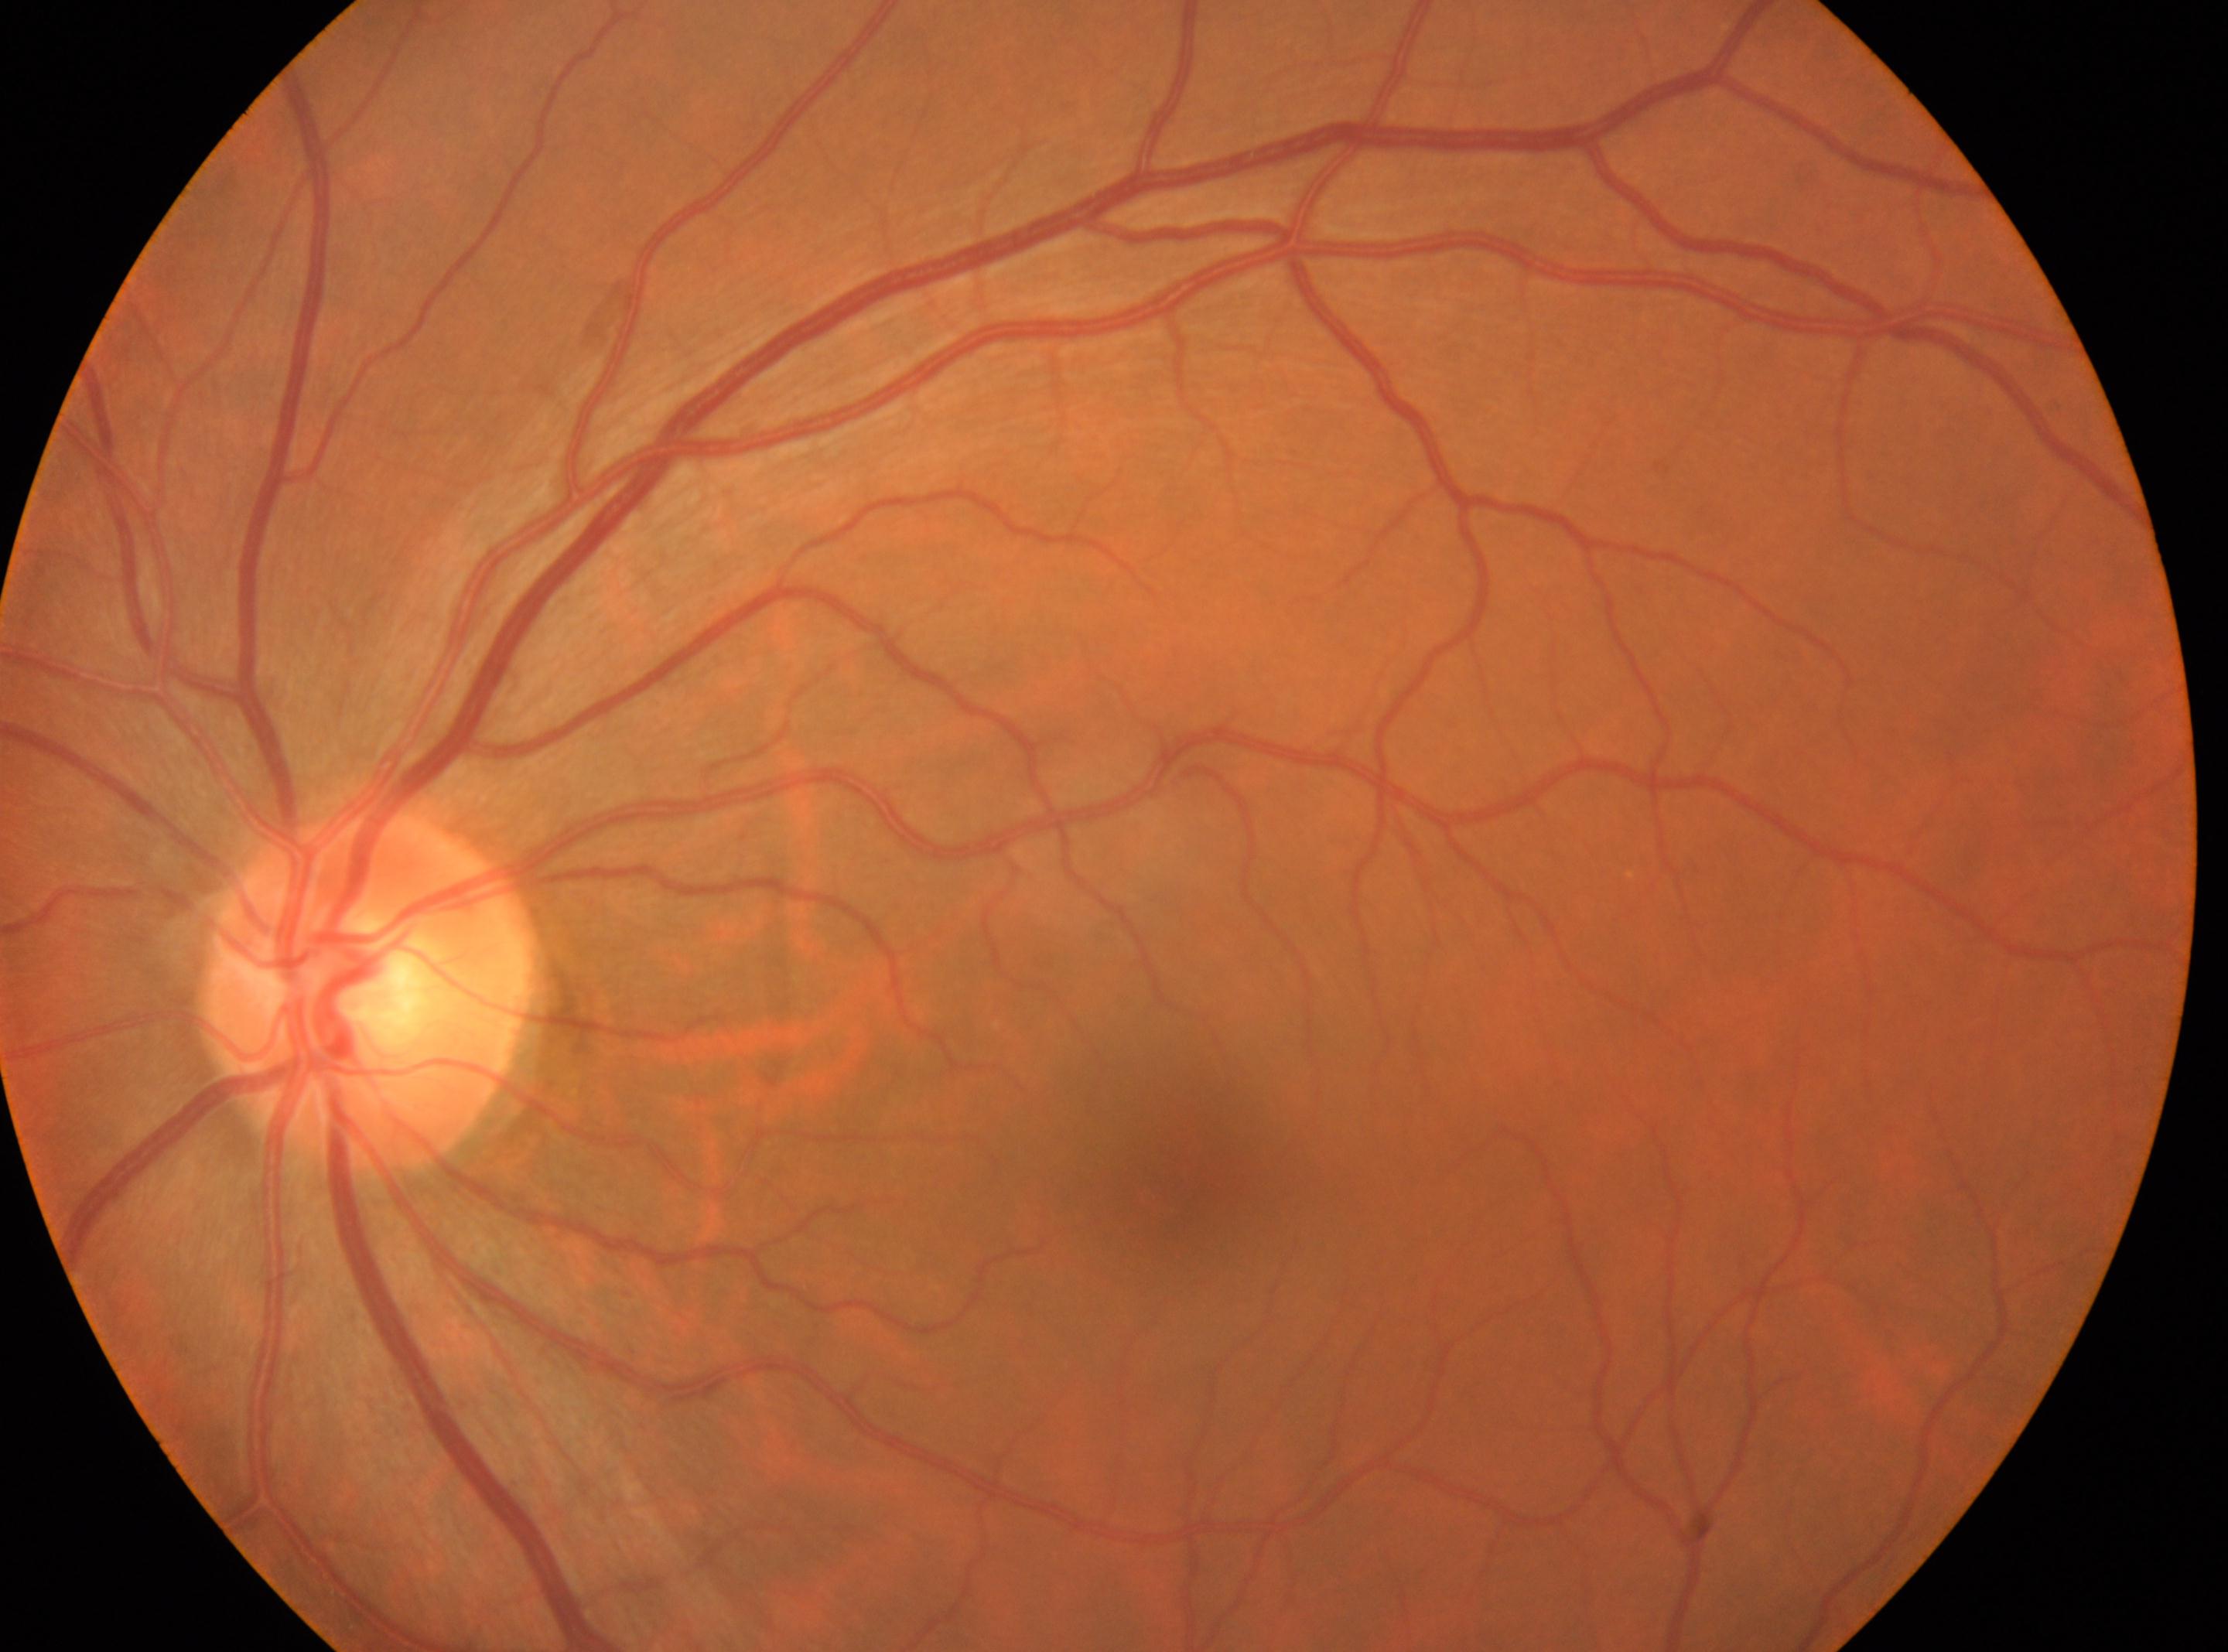 {"dr_grade": "no apparent retinopathy (grade 0)", "eye": "the left eye", "fovea": "1184, 1183", "optic_disc": "365, 992"}